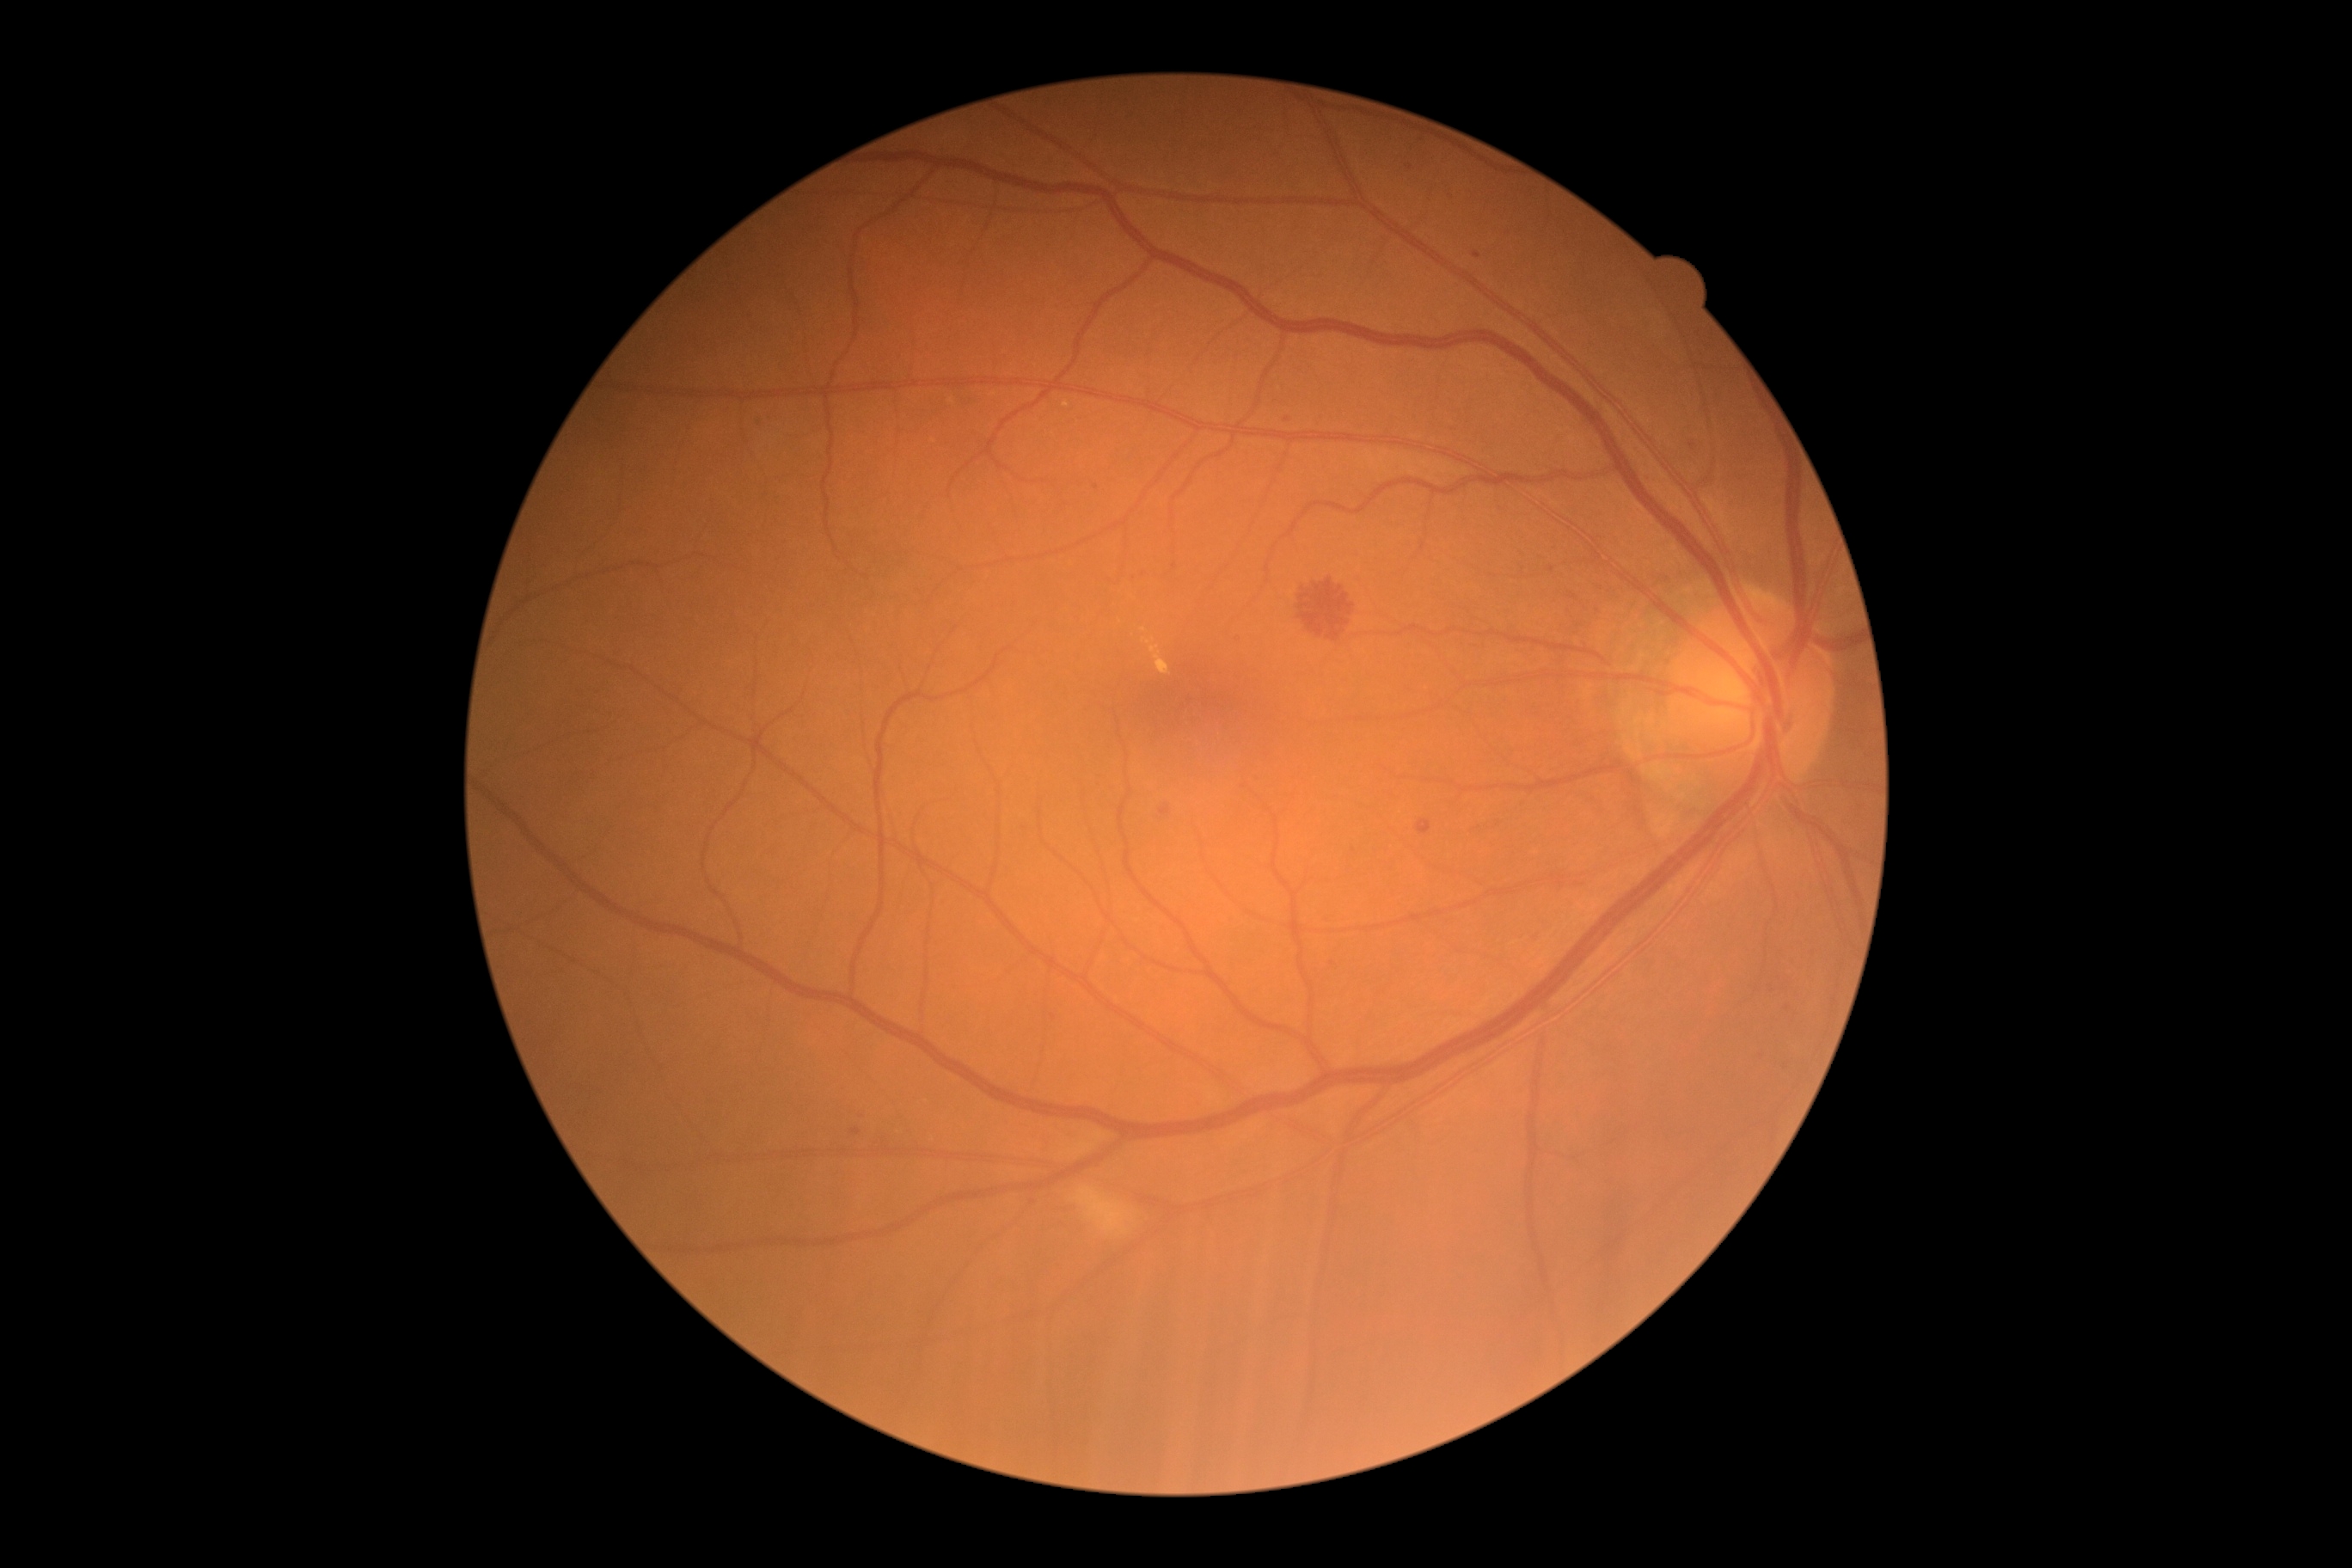

Retinopathy grade is moderate NPDR (2) — more than just microaneurysms but less than severe NPDR.
DR class: non-proliferative diabetic retinopathy.